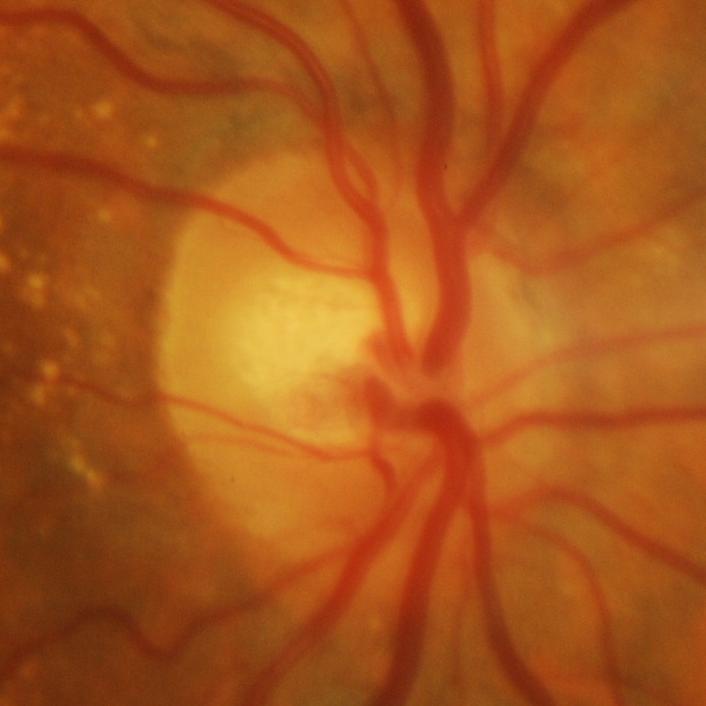
Glaucomatous changes are present. Consistent with glaucomatous optic neuropathy.